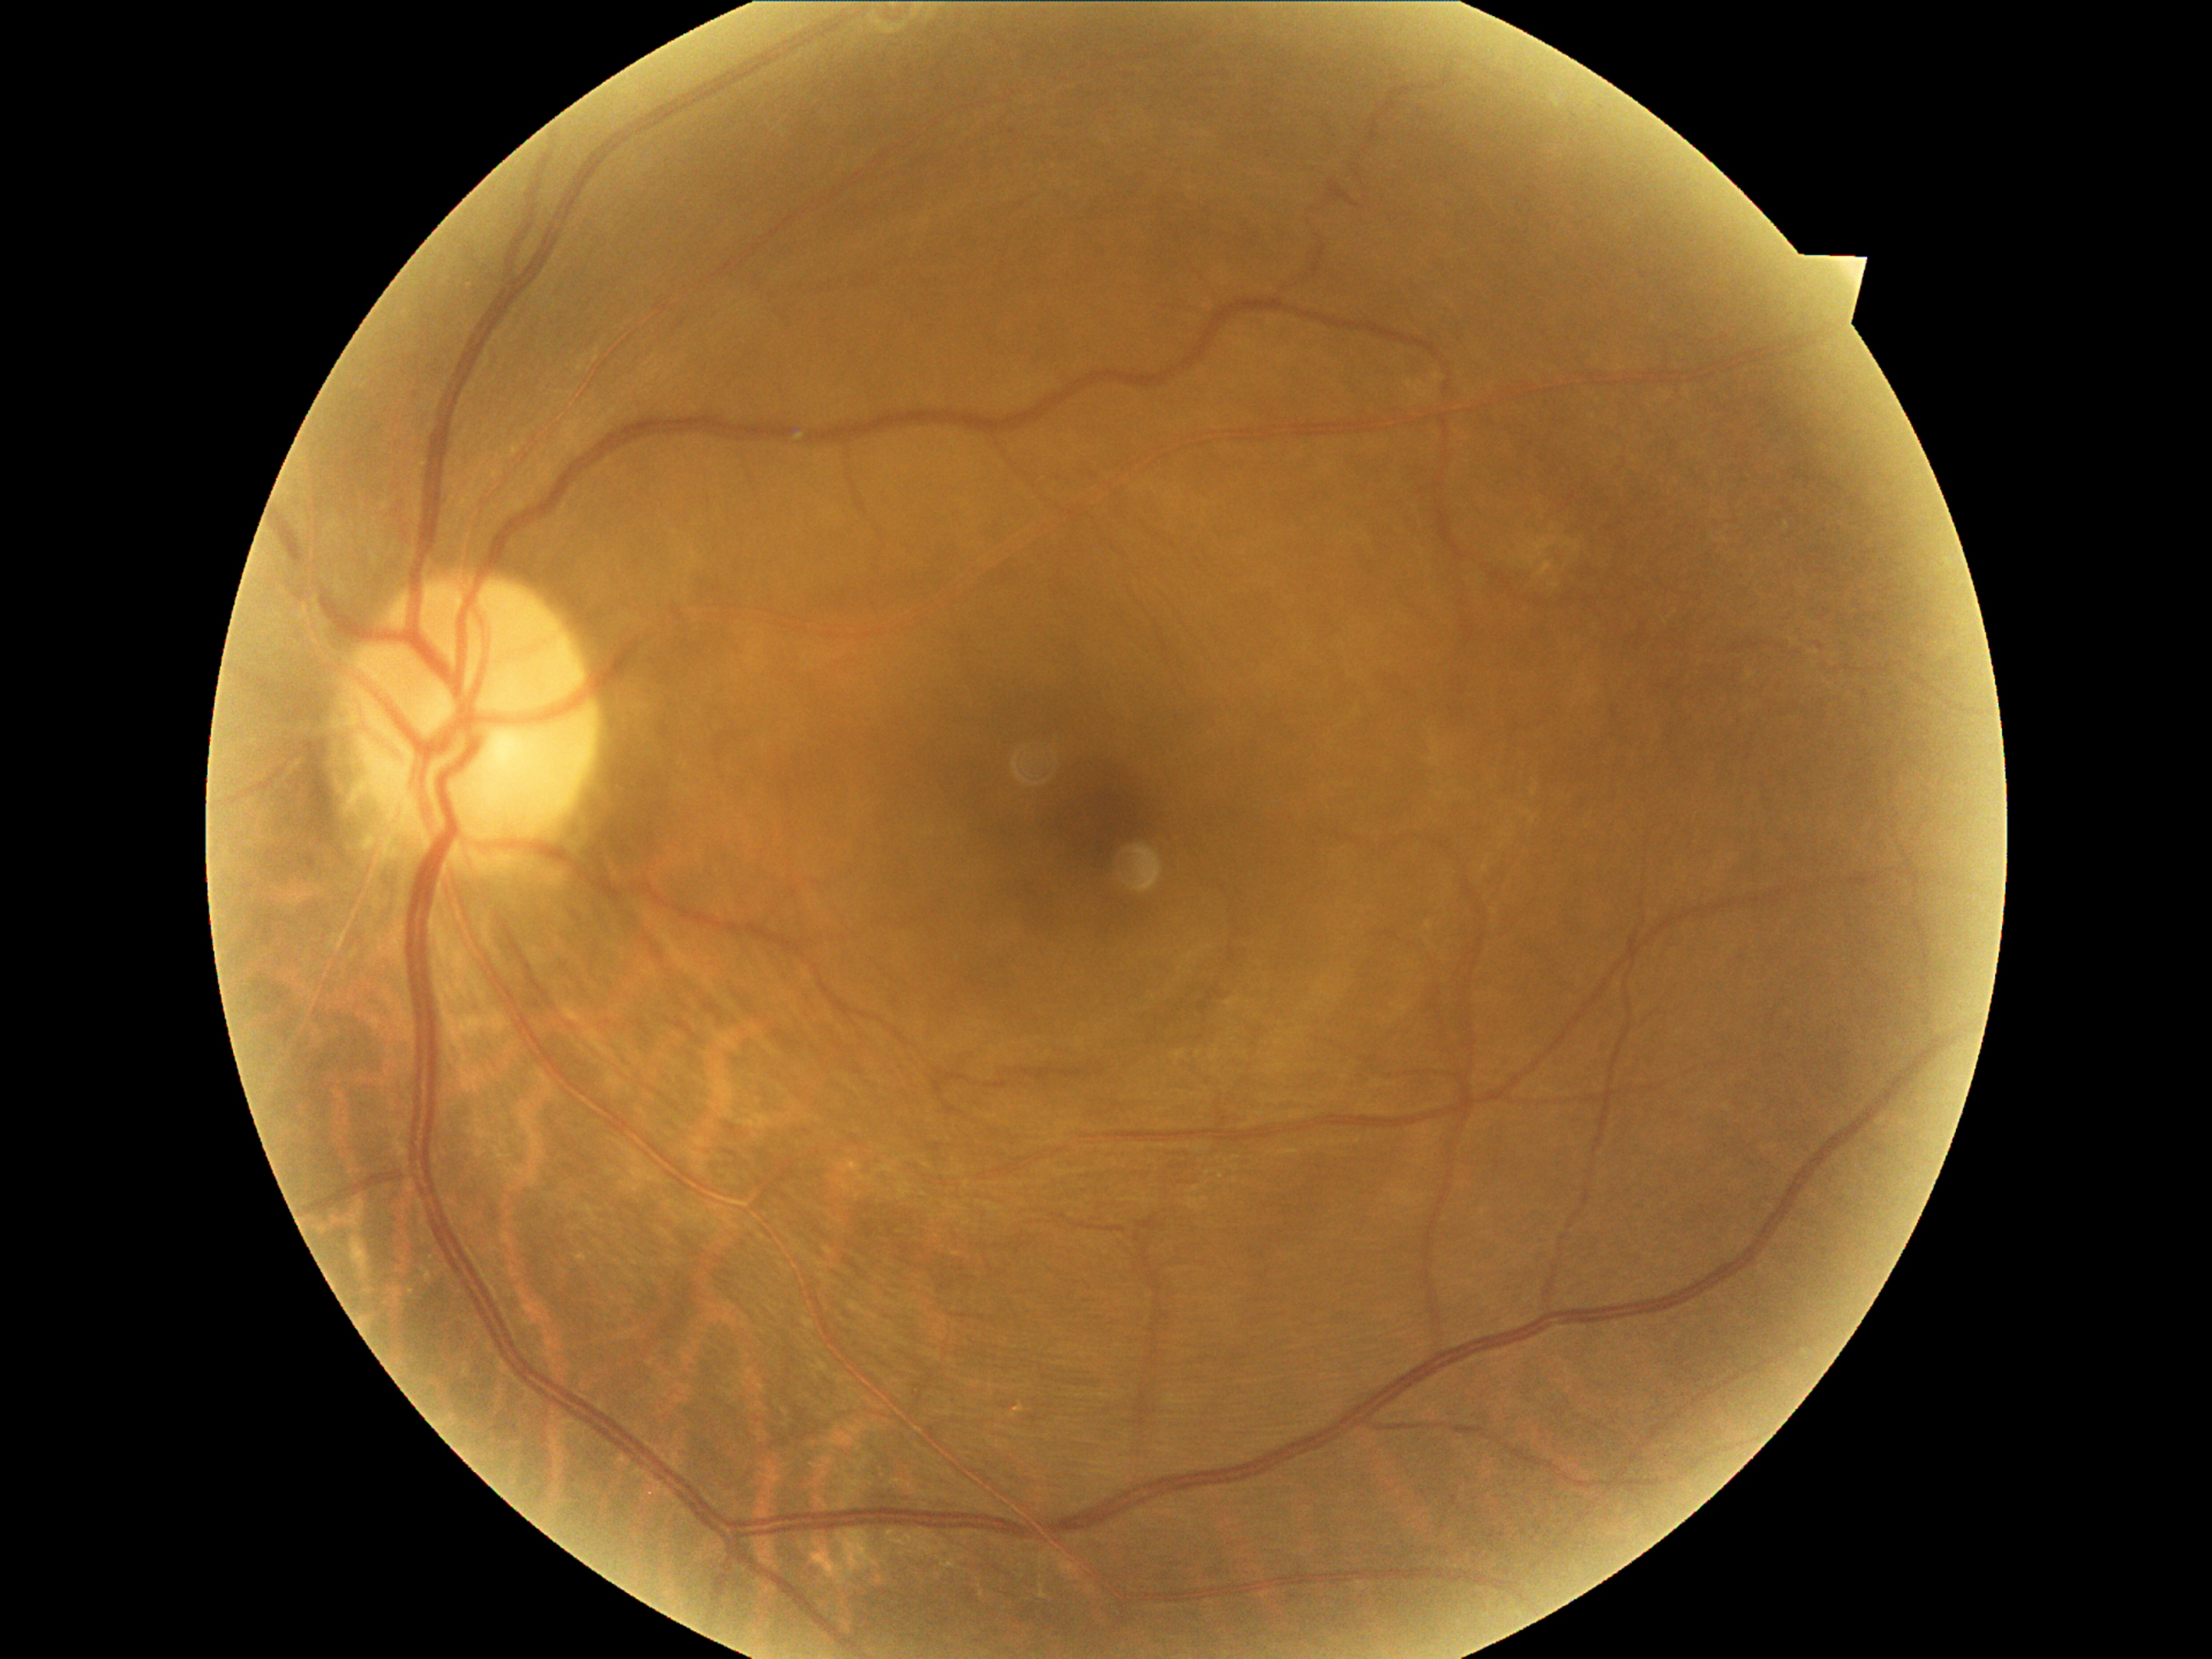

{"dr_grade": "grade 2 (moderate NPDR) — more than just microaneurysms but less than severe NPDR"}